Diabetic retinopathy graded by the modified Davis classification.
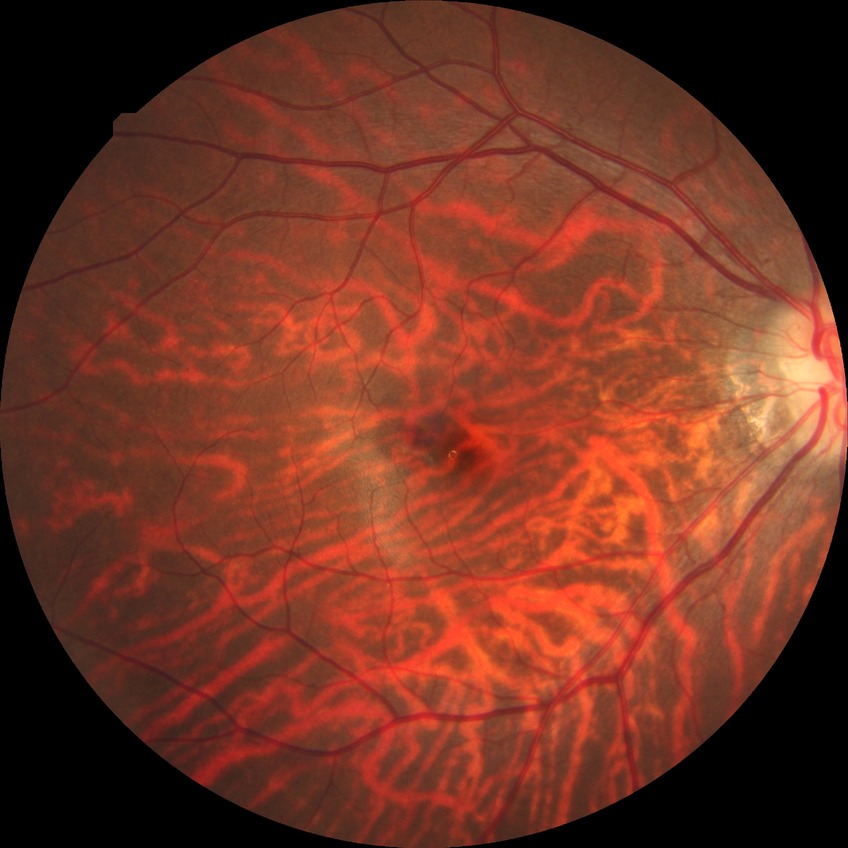

Diabetic retinopathy (DR): NDR (no diabetic retinopathy).